848 by 848 pixels; CFP; nonmydriatic:
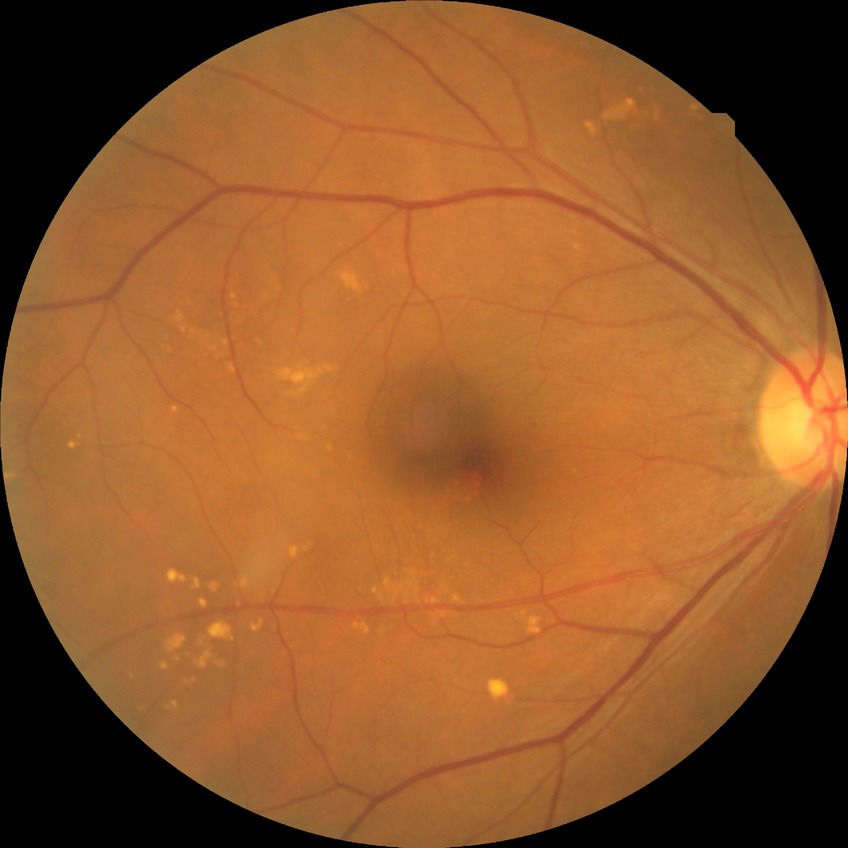 Modified Davis classification is no diabetic retinopathy.